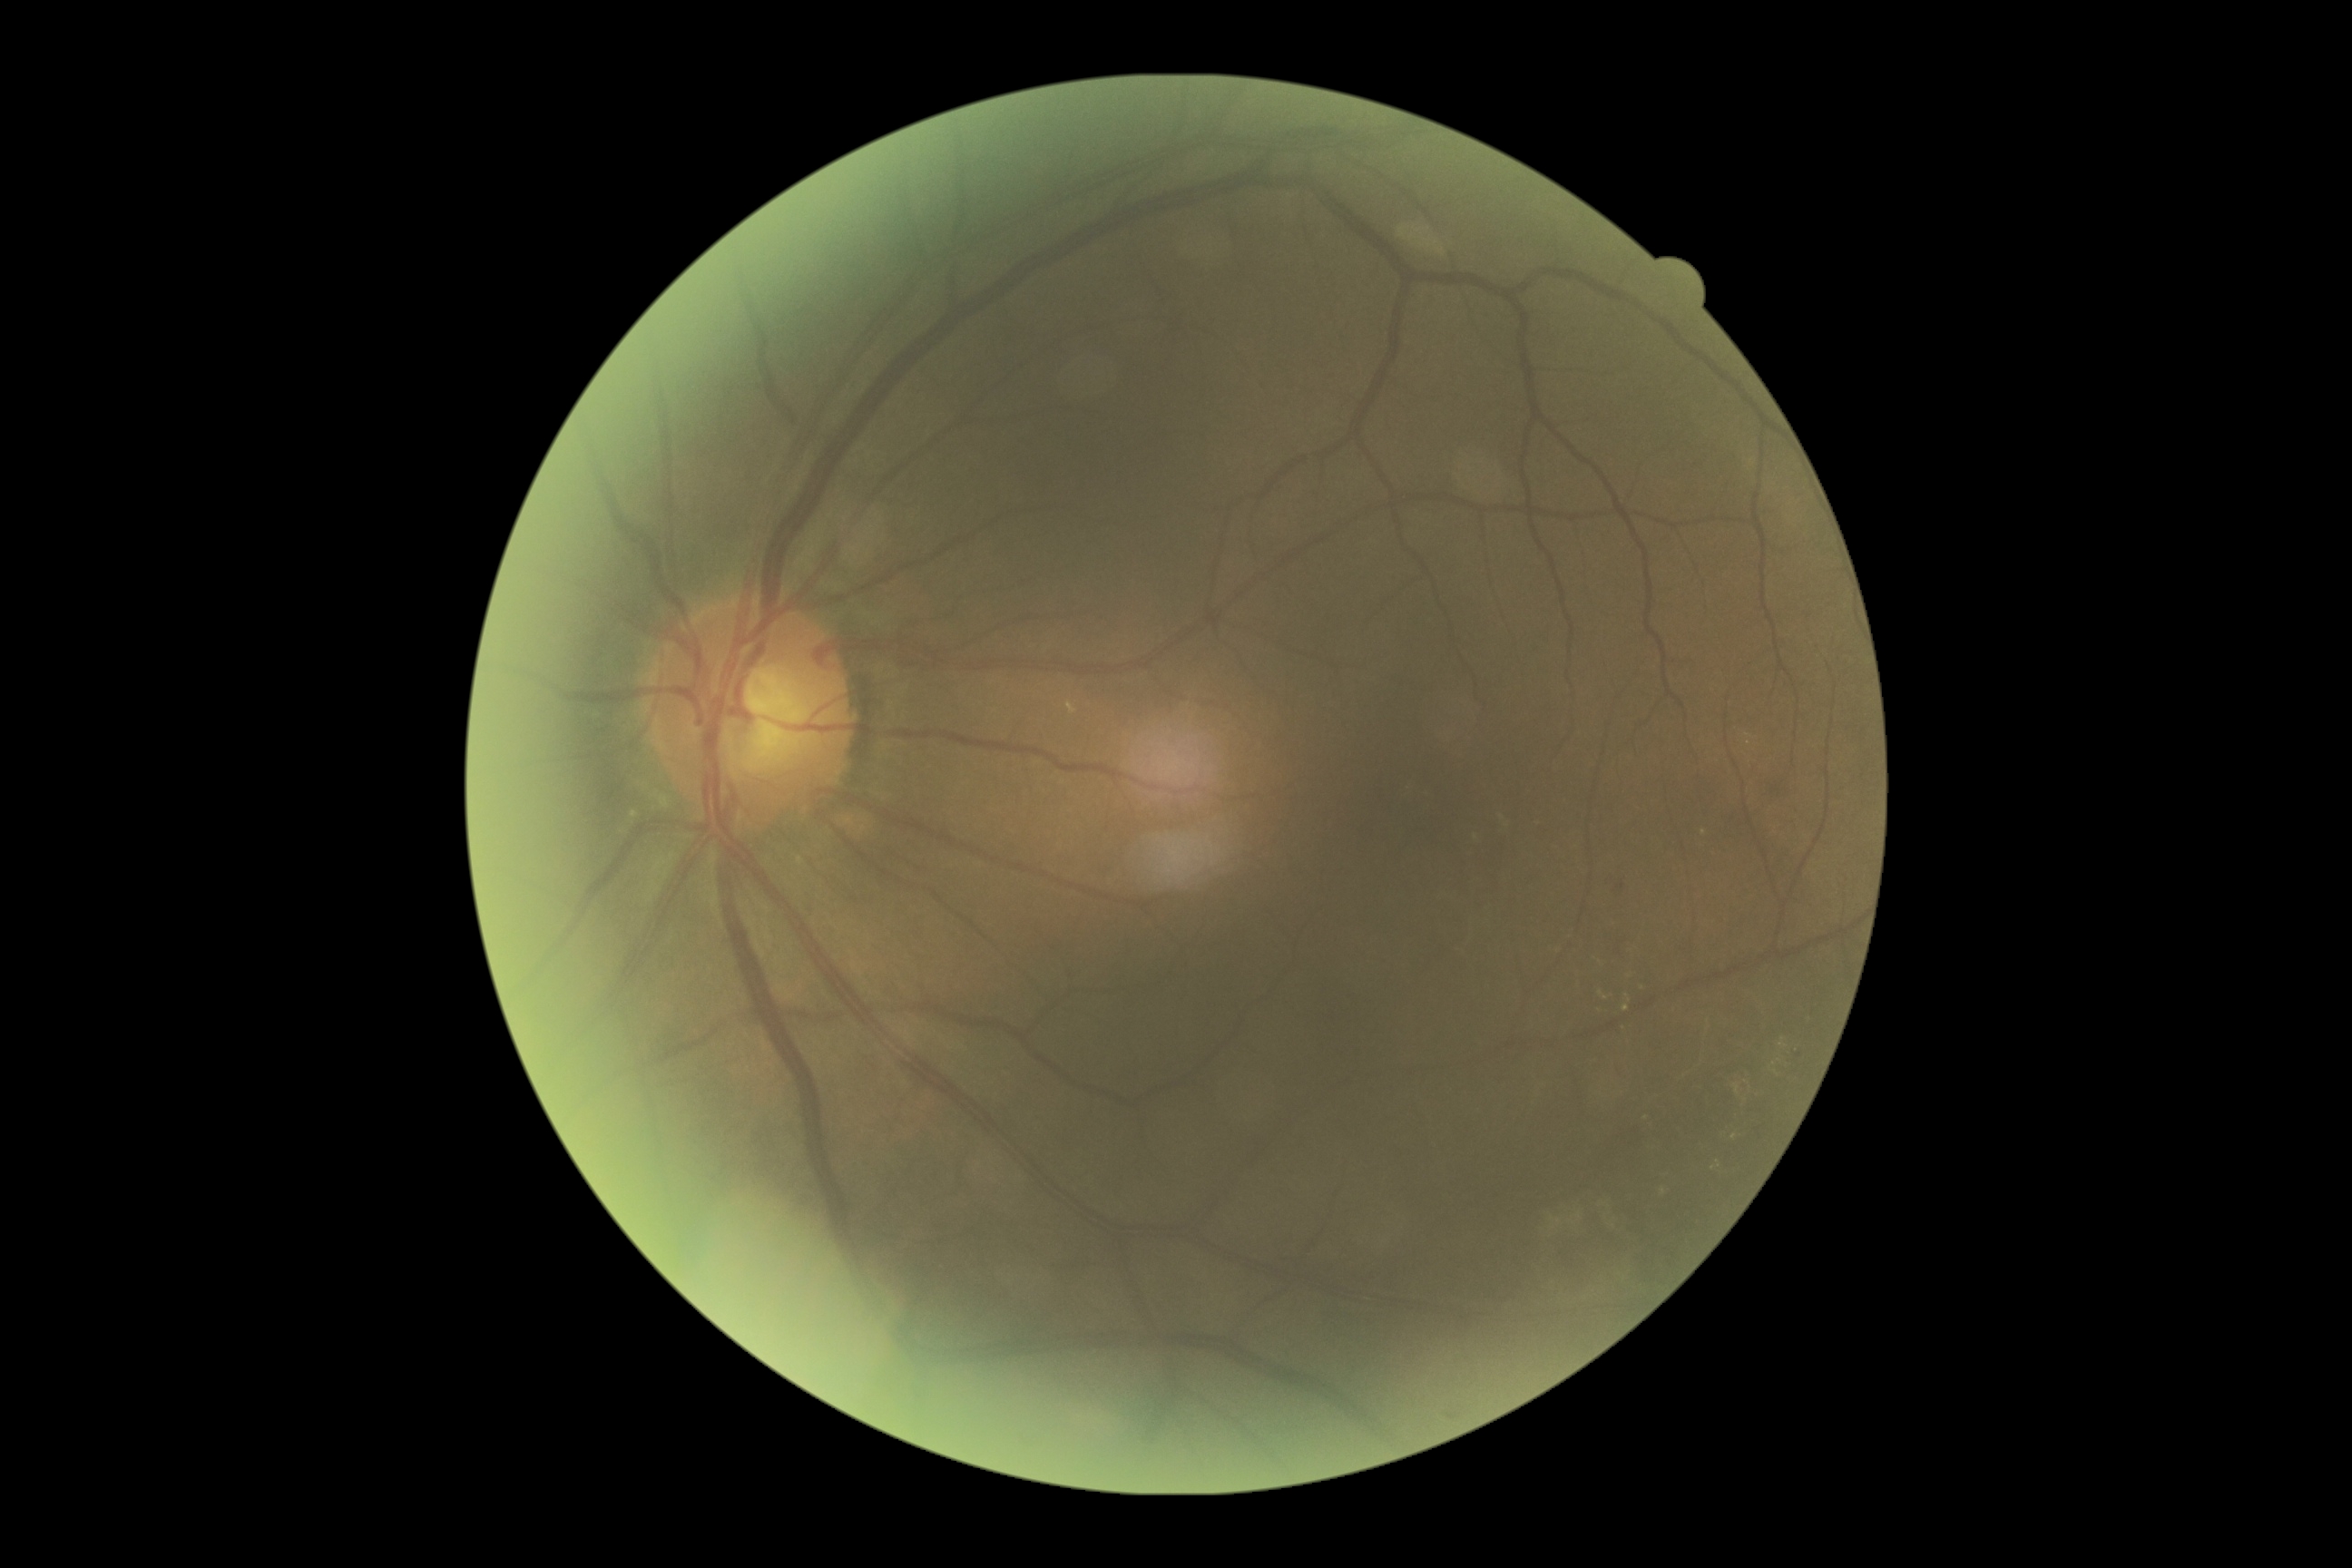

retinopathy grade: moderate non-proliferative diabetic retinopathy (2) — more than just microaneurysms but less than severe NPDR.